Color fundus image: 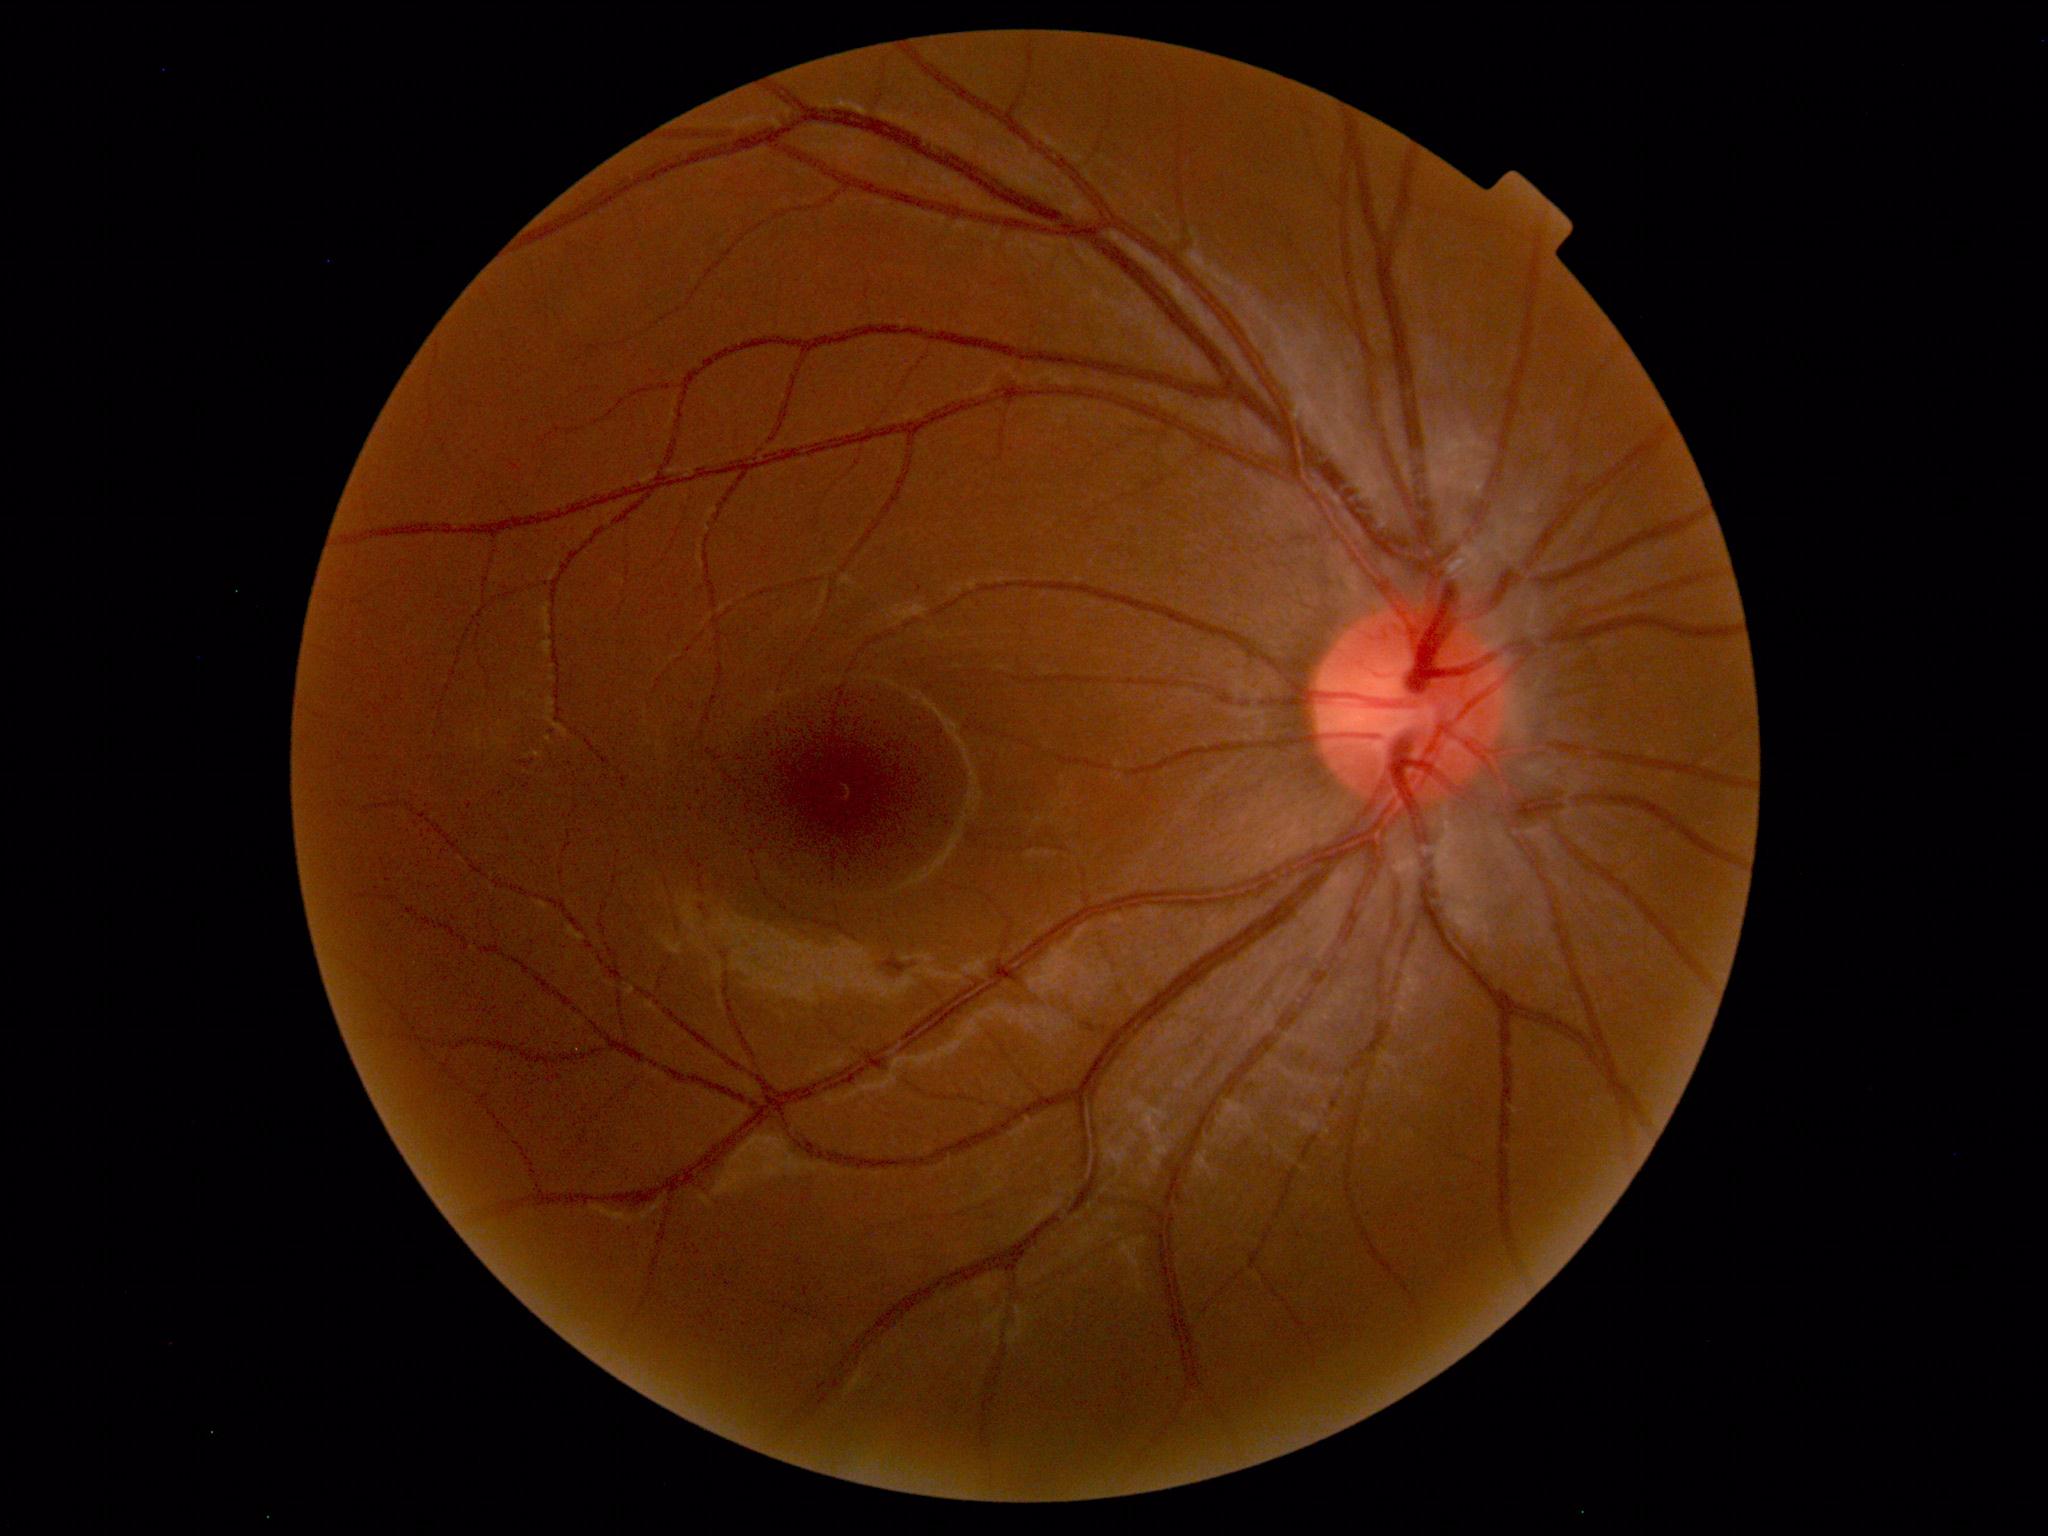 Diagnosis: normal.